Infant wide-field retinal image
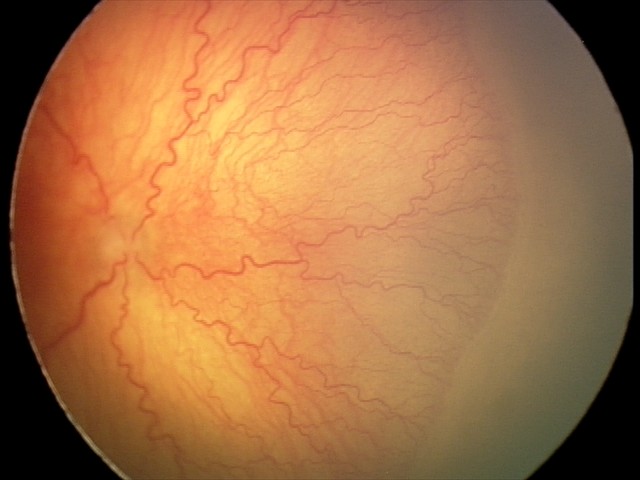
Plus disease was diagnosed. Screening series with A-ROP (aggressive ROP).